Pediatric retinal photograph (wide-field)
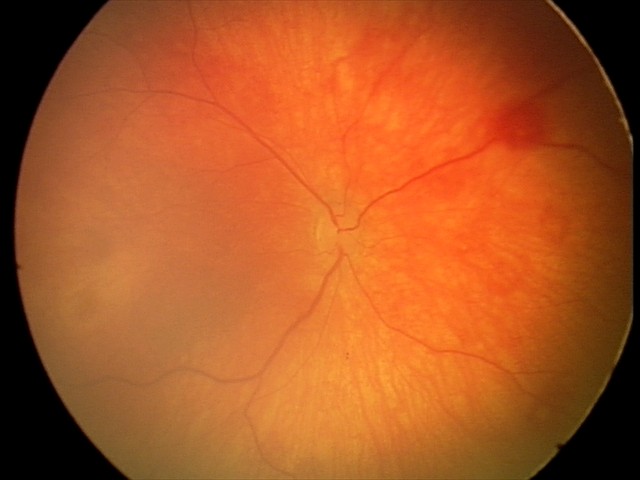 Q: What was the screening finding?
A: physiological finding